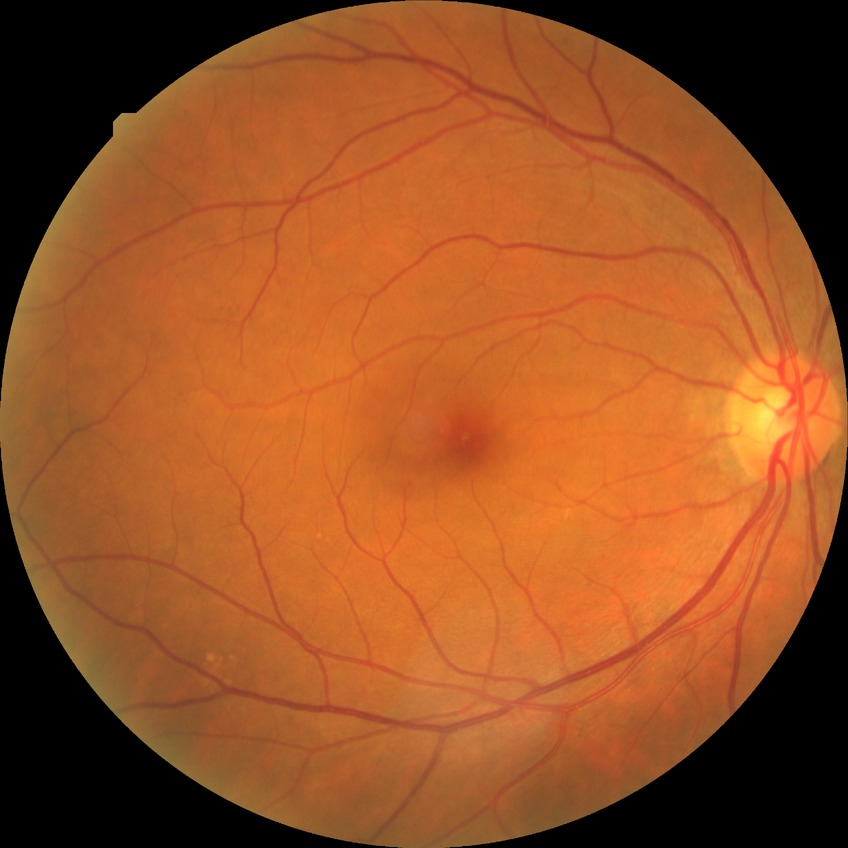
Modified Davis grading is no diabetic retinopathy.